Diabetic retinopathy graded by the modified Davis classification. Retinal fundus photograph.
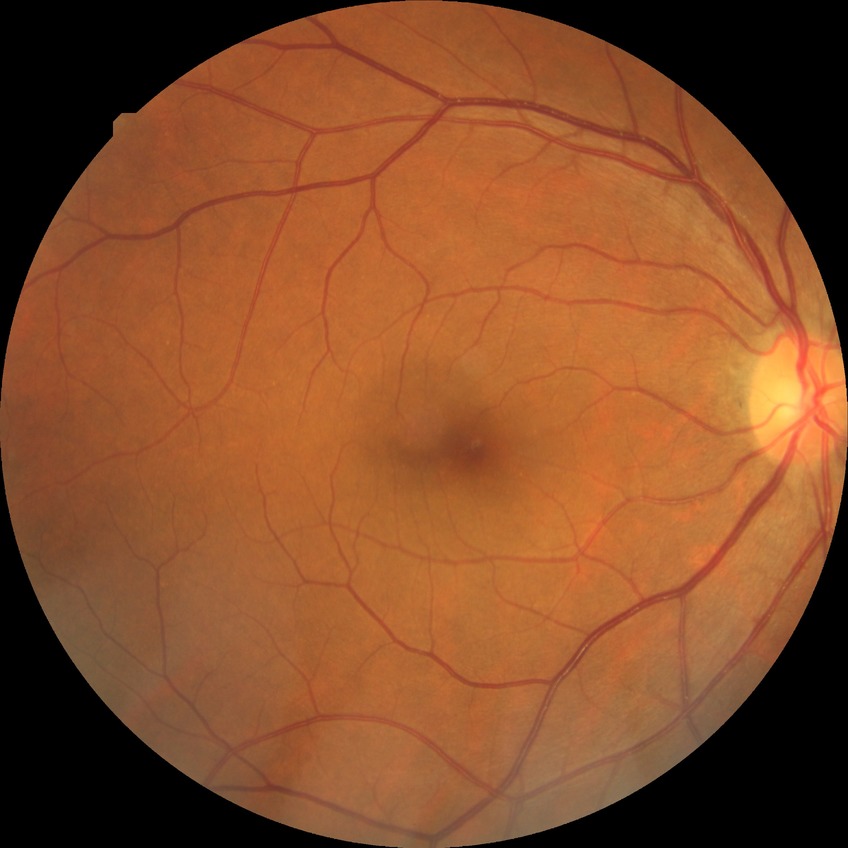
Diabetic retinopathy (DR): no diabetic retinopathy (NDR).